Image size 2352x1568, 45° field of view:
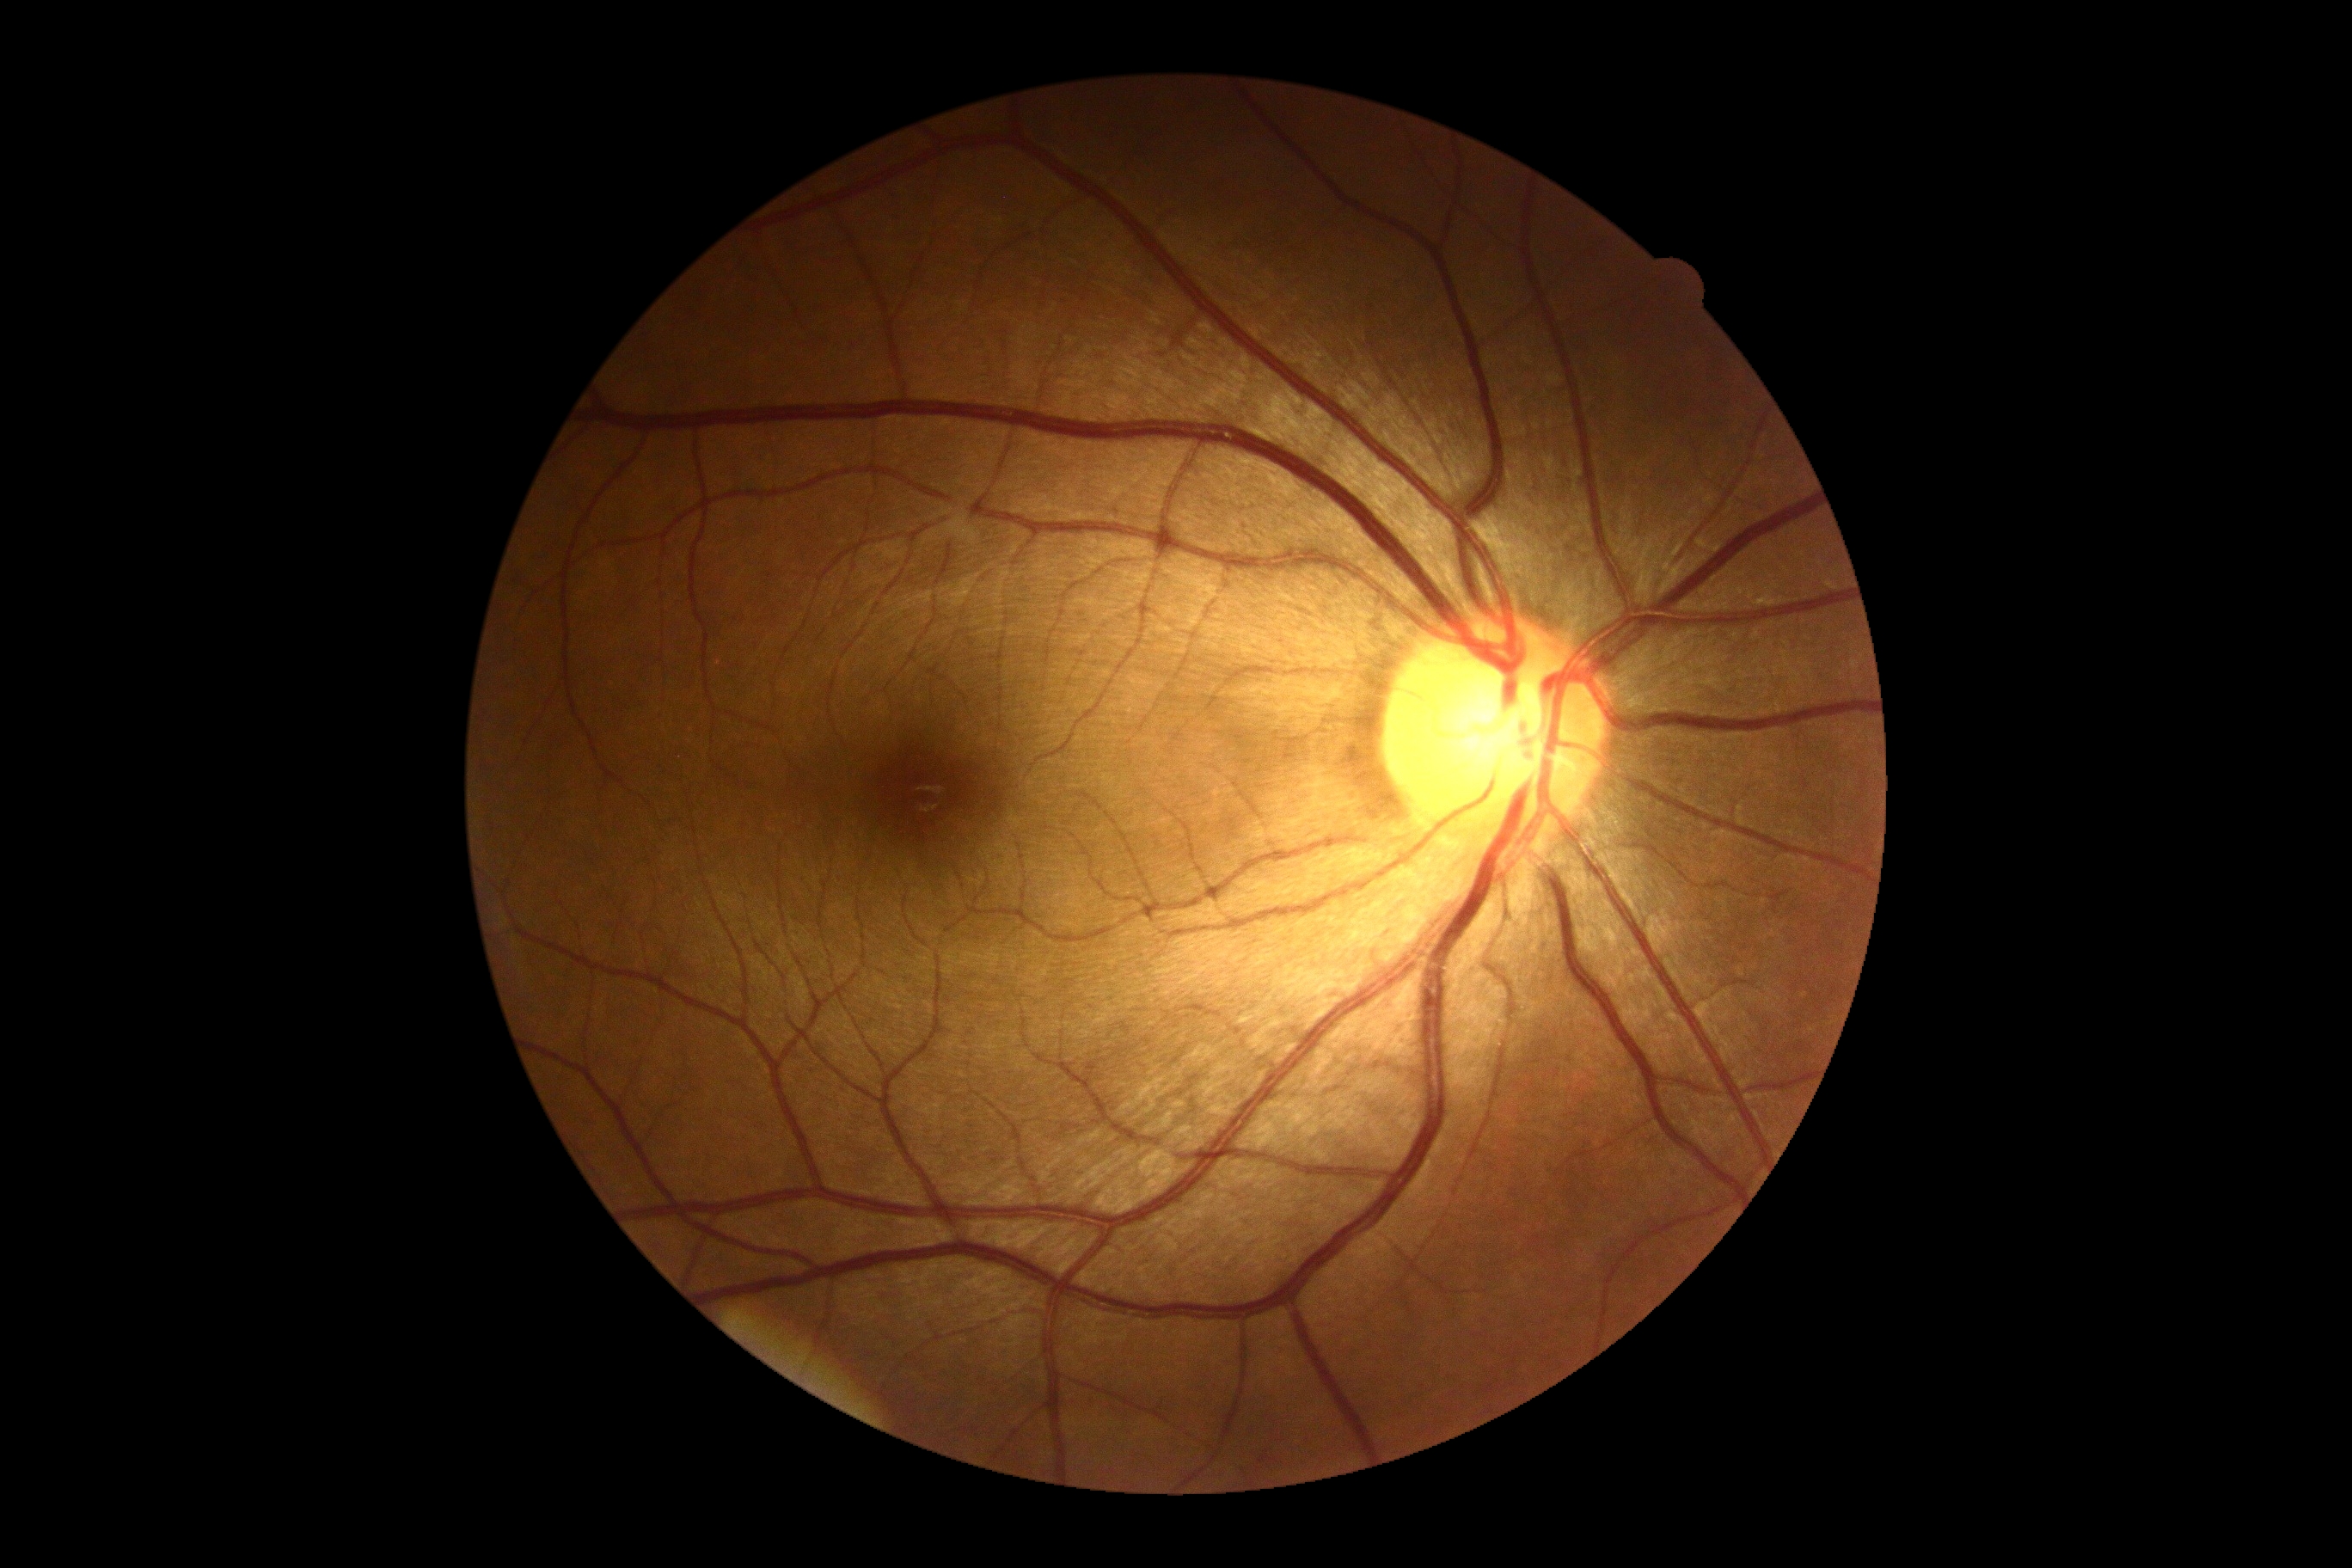 DR: no apparent diabetic retinopathy (grade 0) — no visible signs of diabetic retinopathy.